CFP, 733 x 715 pixels:
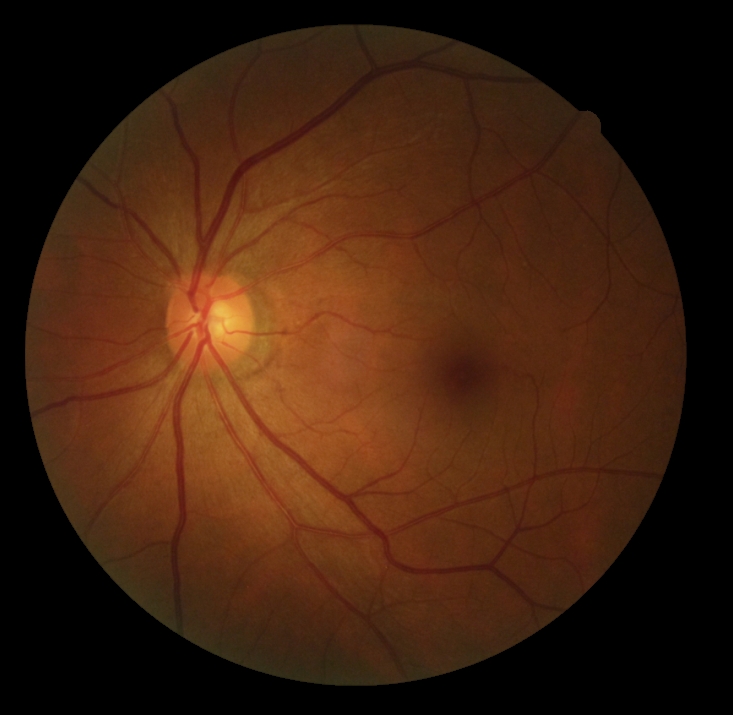
DR: grade 0 (no apparent retinopathy) — no visible signs of diabetic retinopathy.